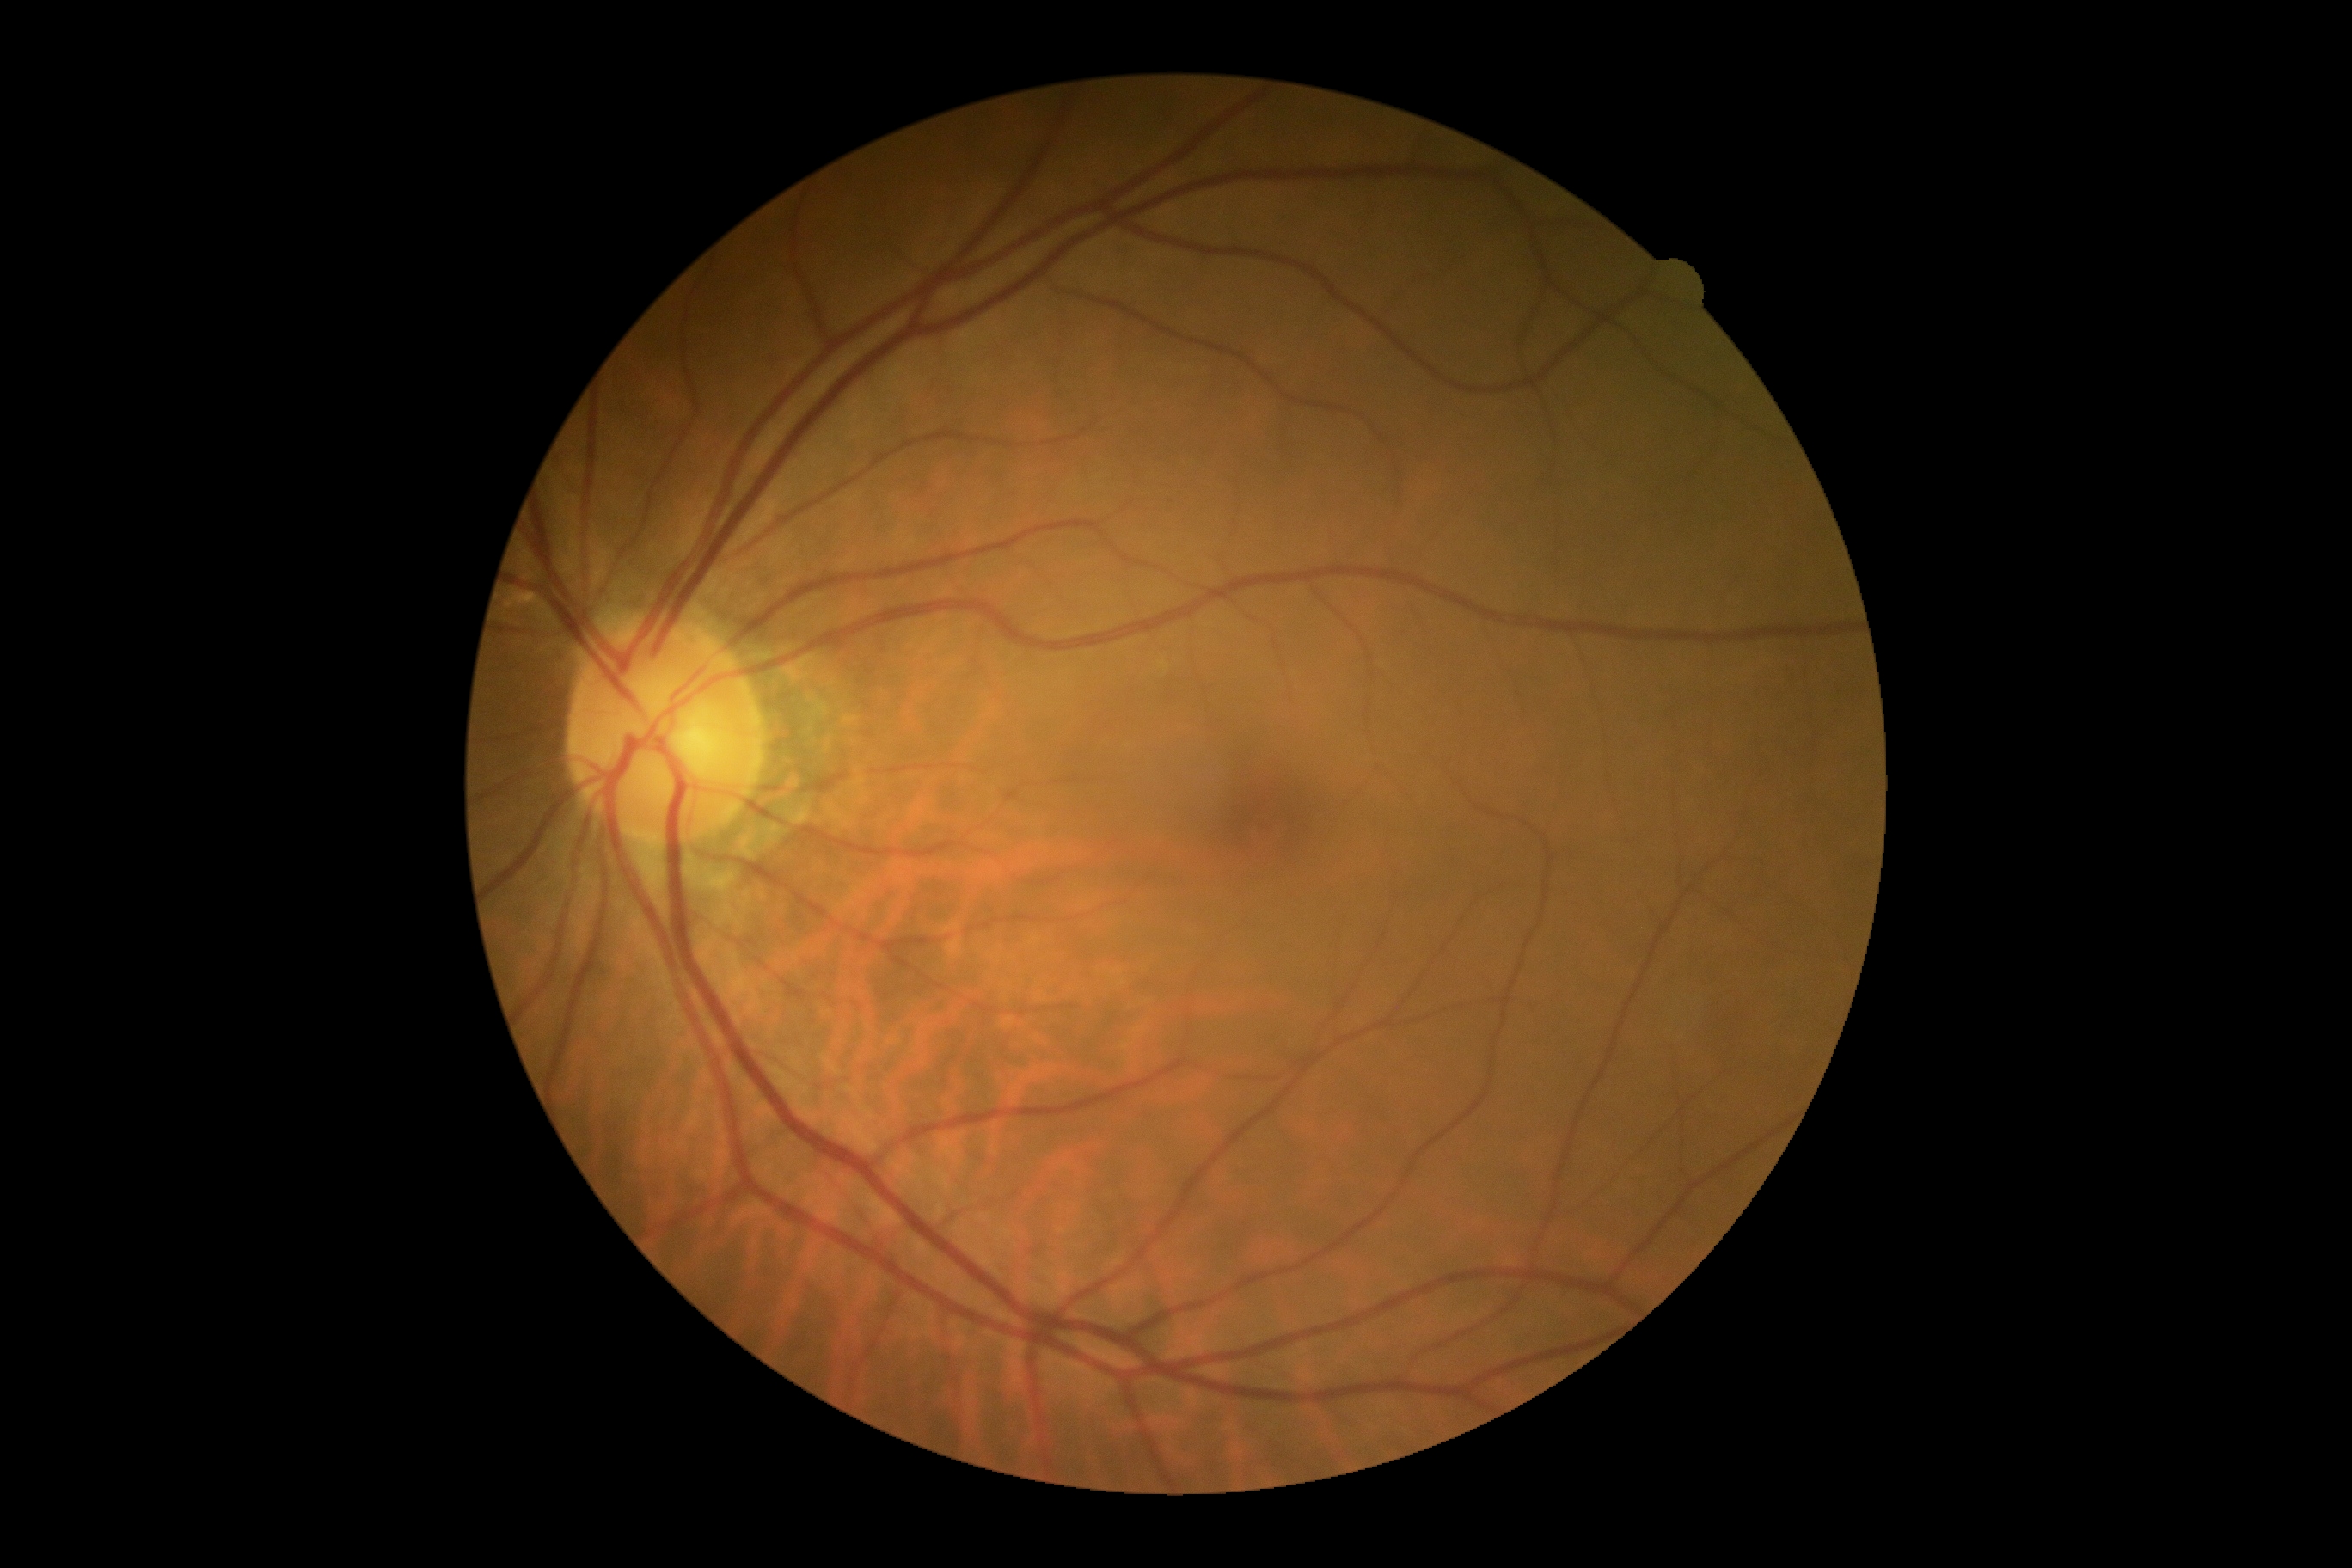 No diabetic retinal disease findings. Diabetic retinopathy is 0.